Color fundus photograph. 412x310 — 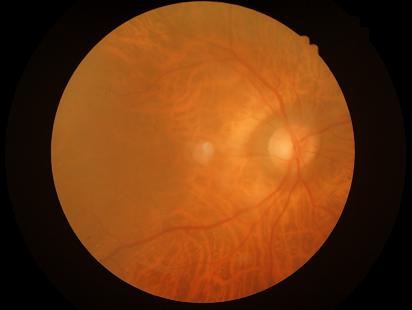 Quality assessment: clarity: noticeable blur in the optic disc, vessels, or background | contrast: wide intensity range, structures distinguishable | overall: inadequate for clinical interpretation.